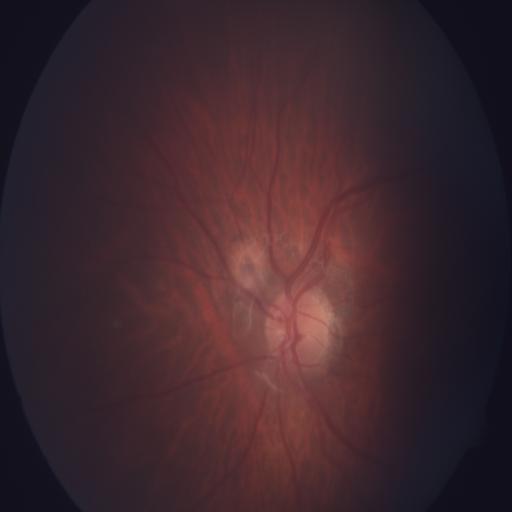 Impression: tessellation.